Color fundus photograph. 2352 x 1568 pixels. 45° FOV
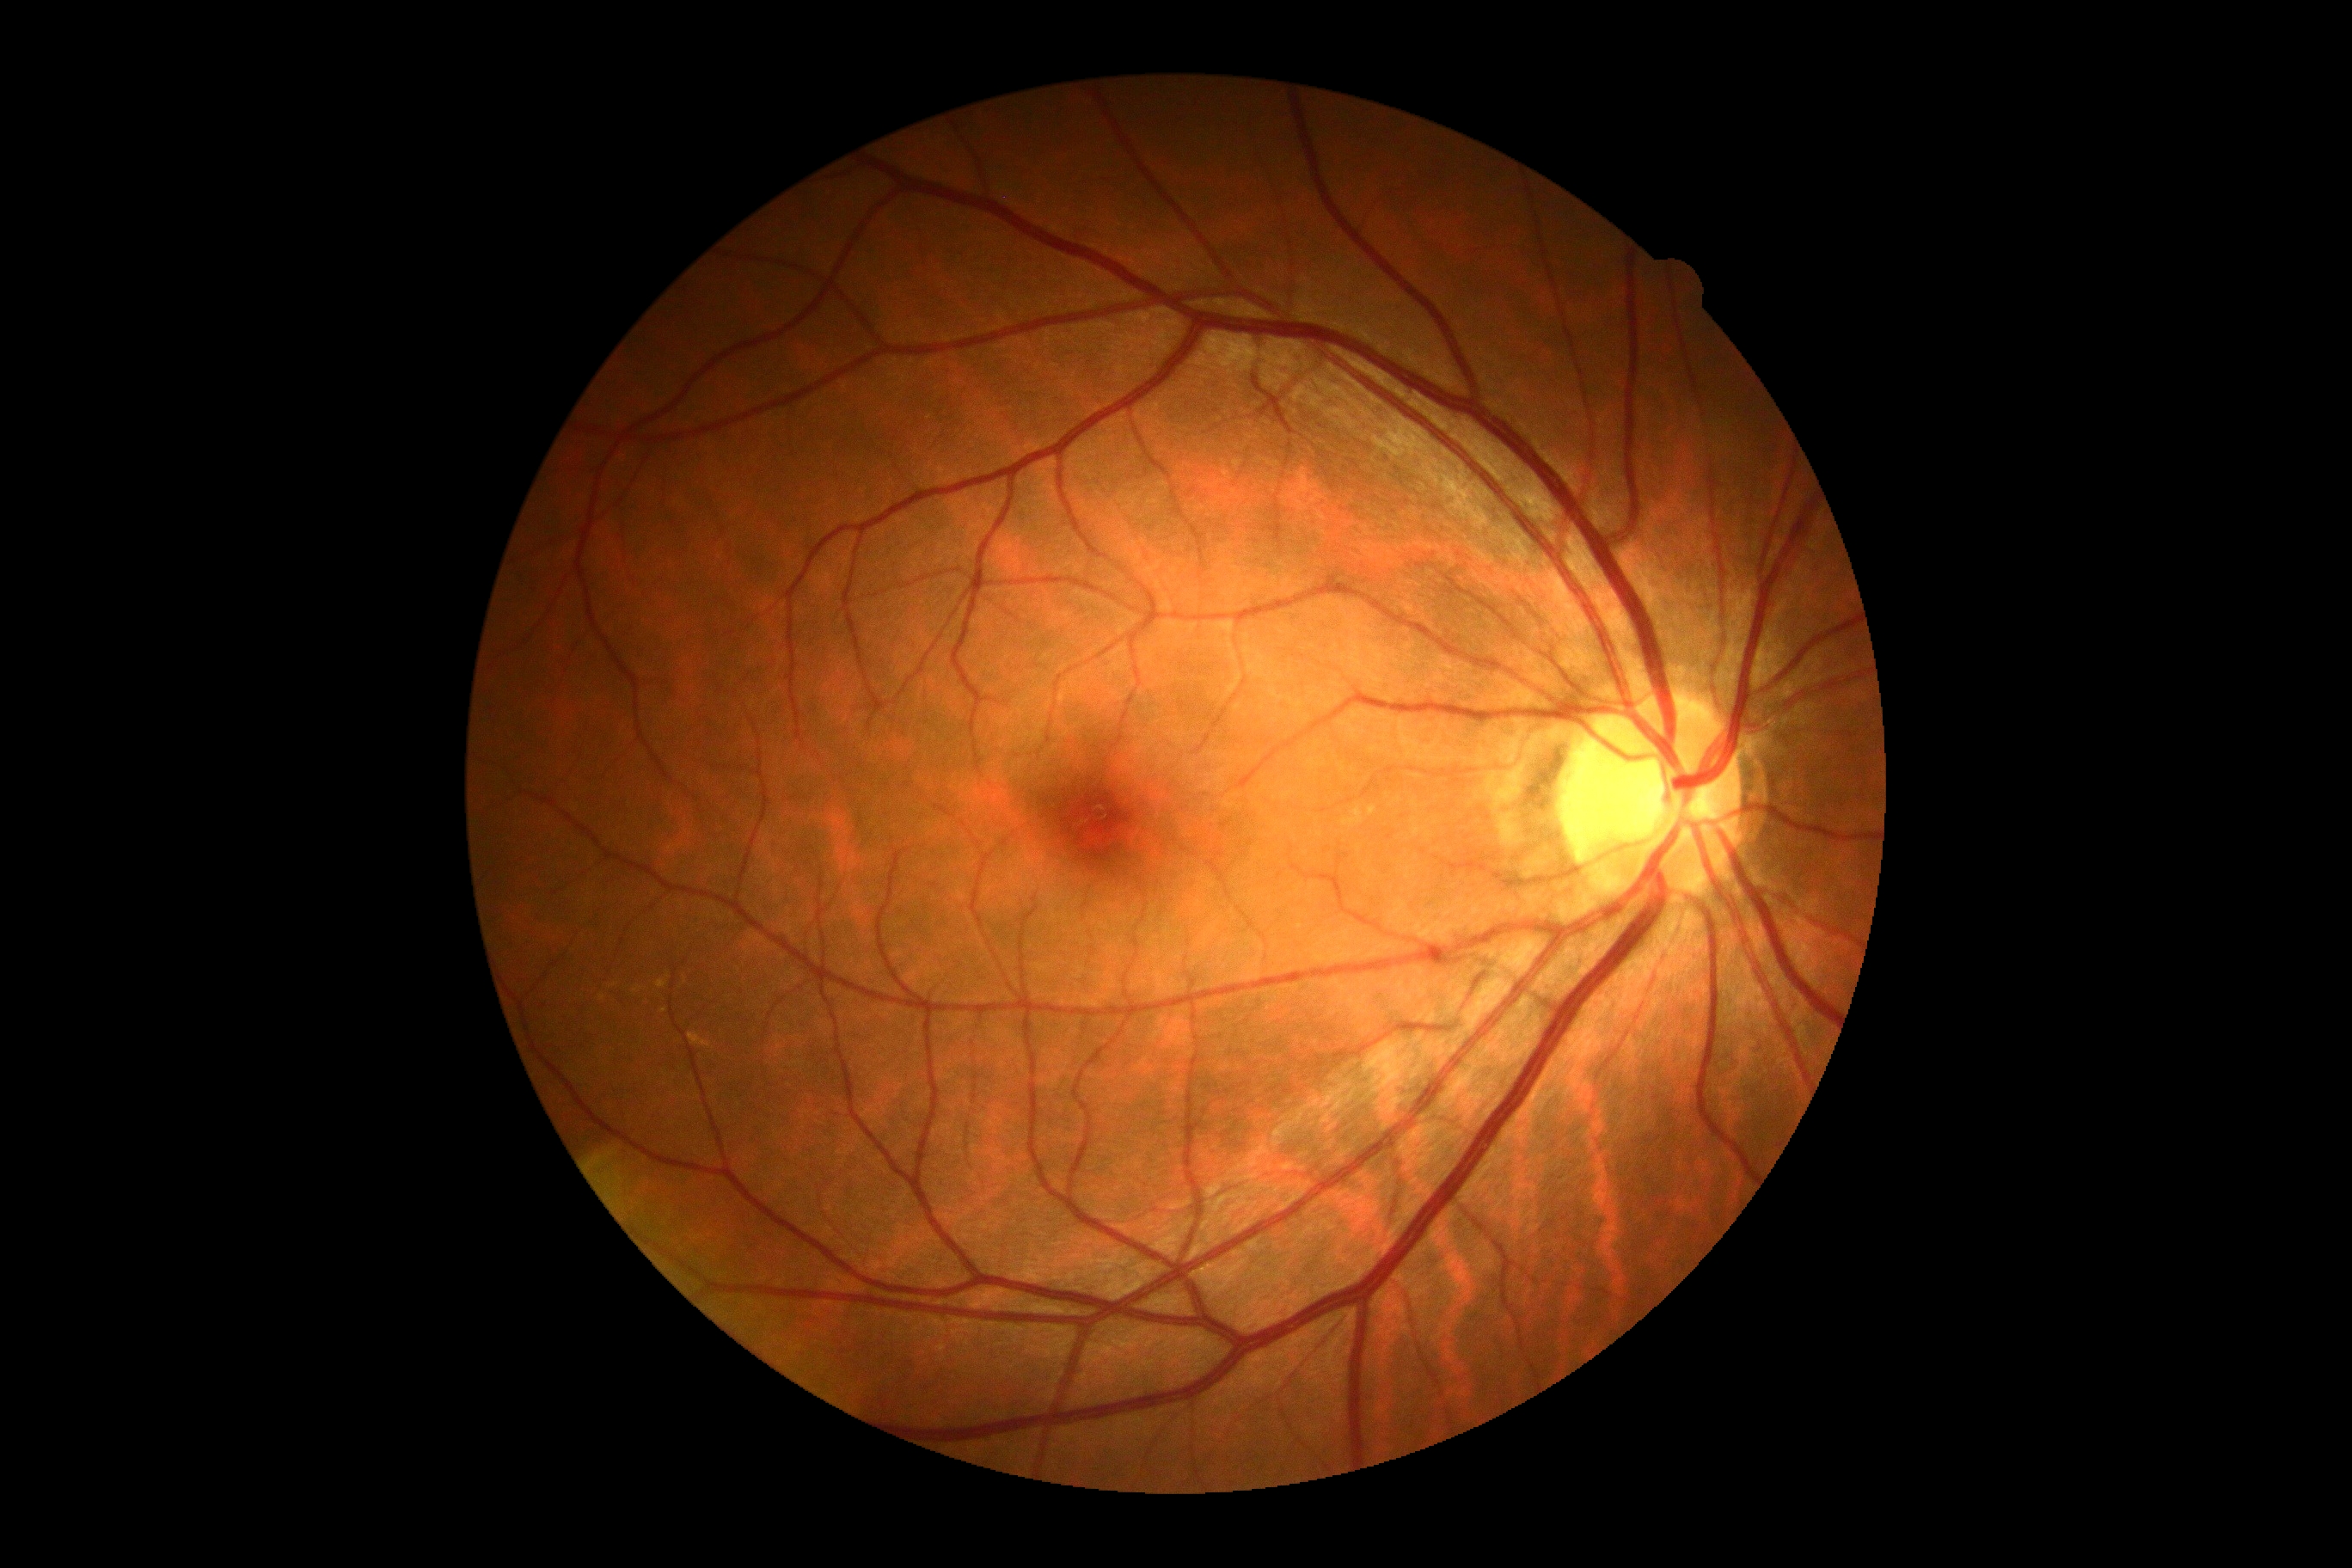

DR impression=negative for DR, DR stage=0/4.